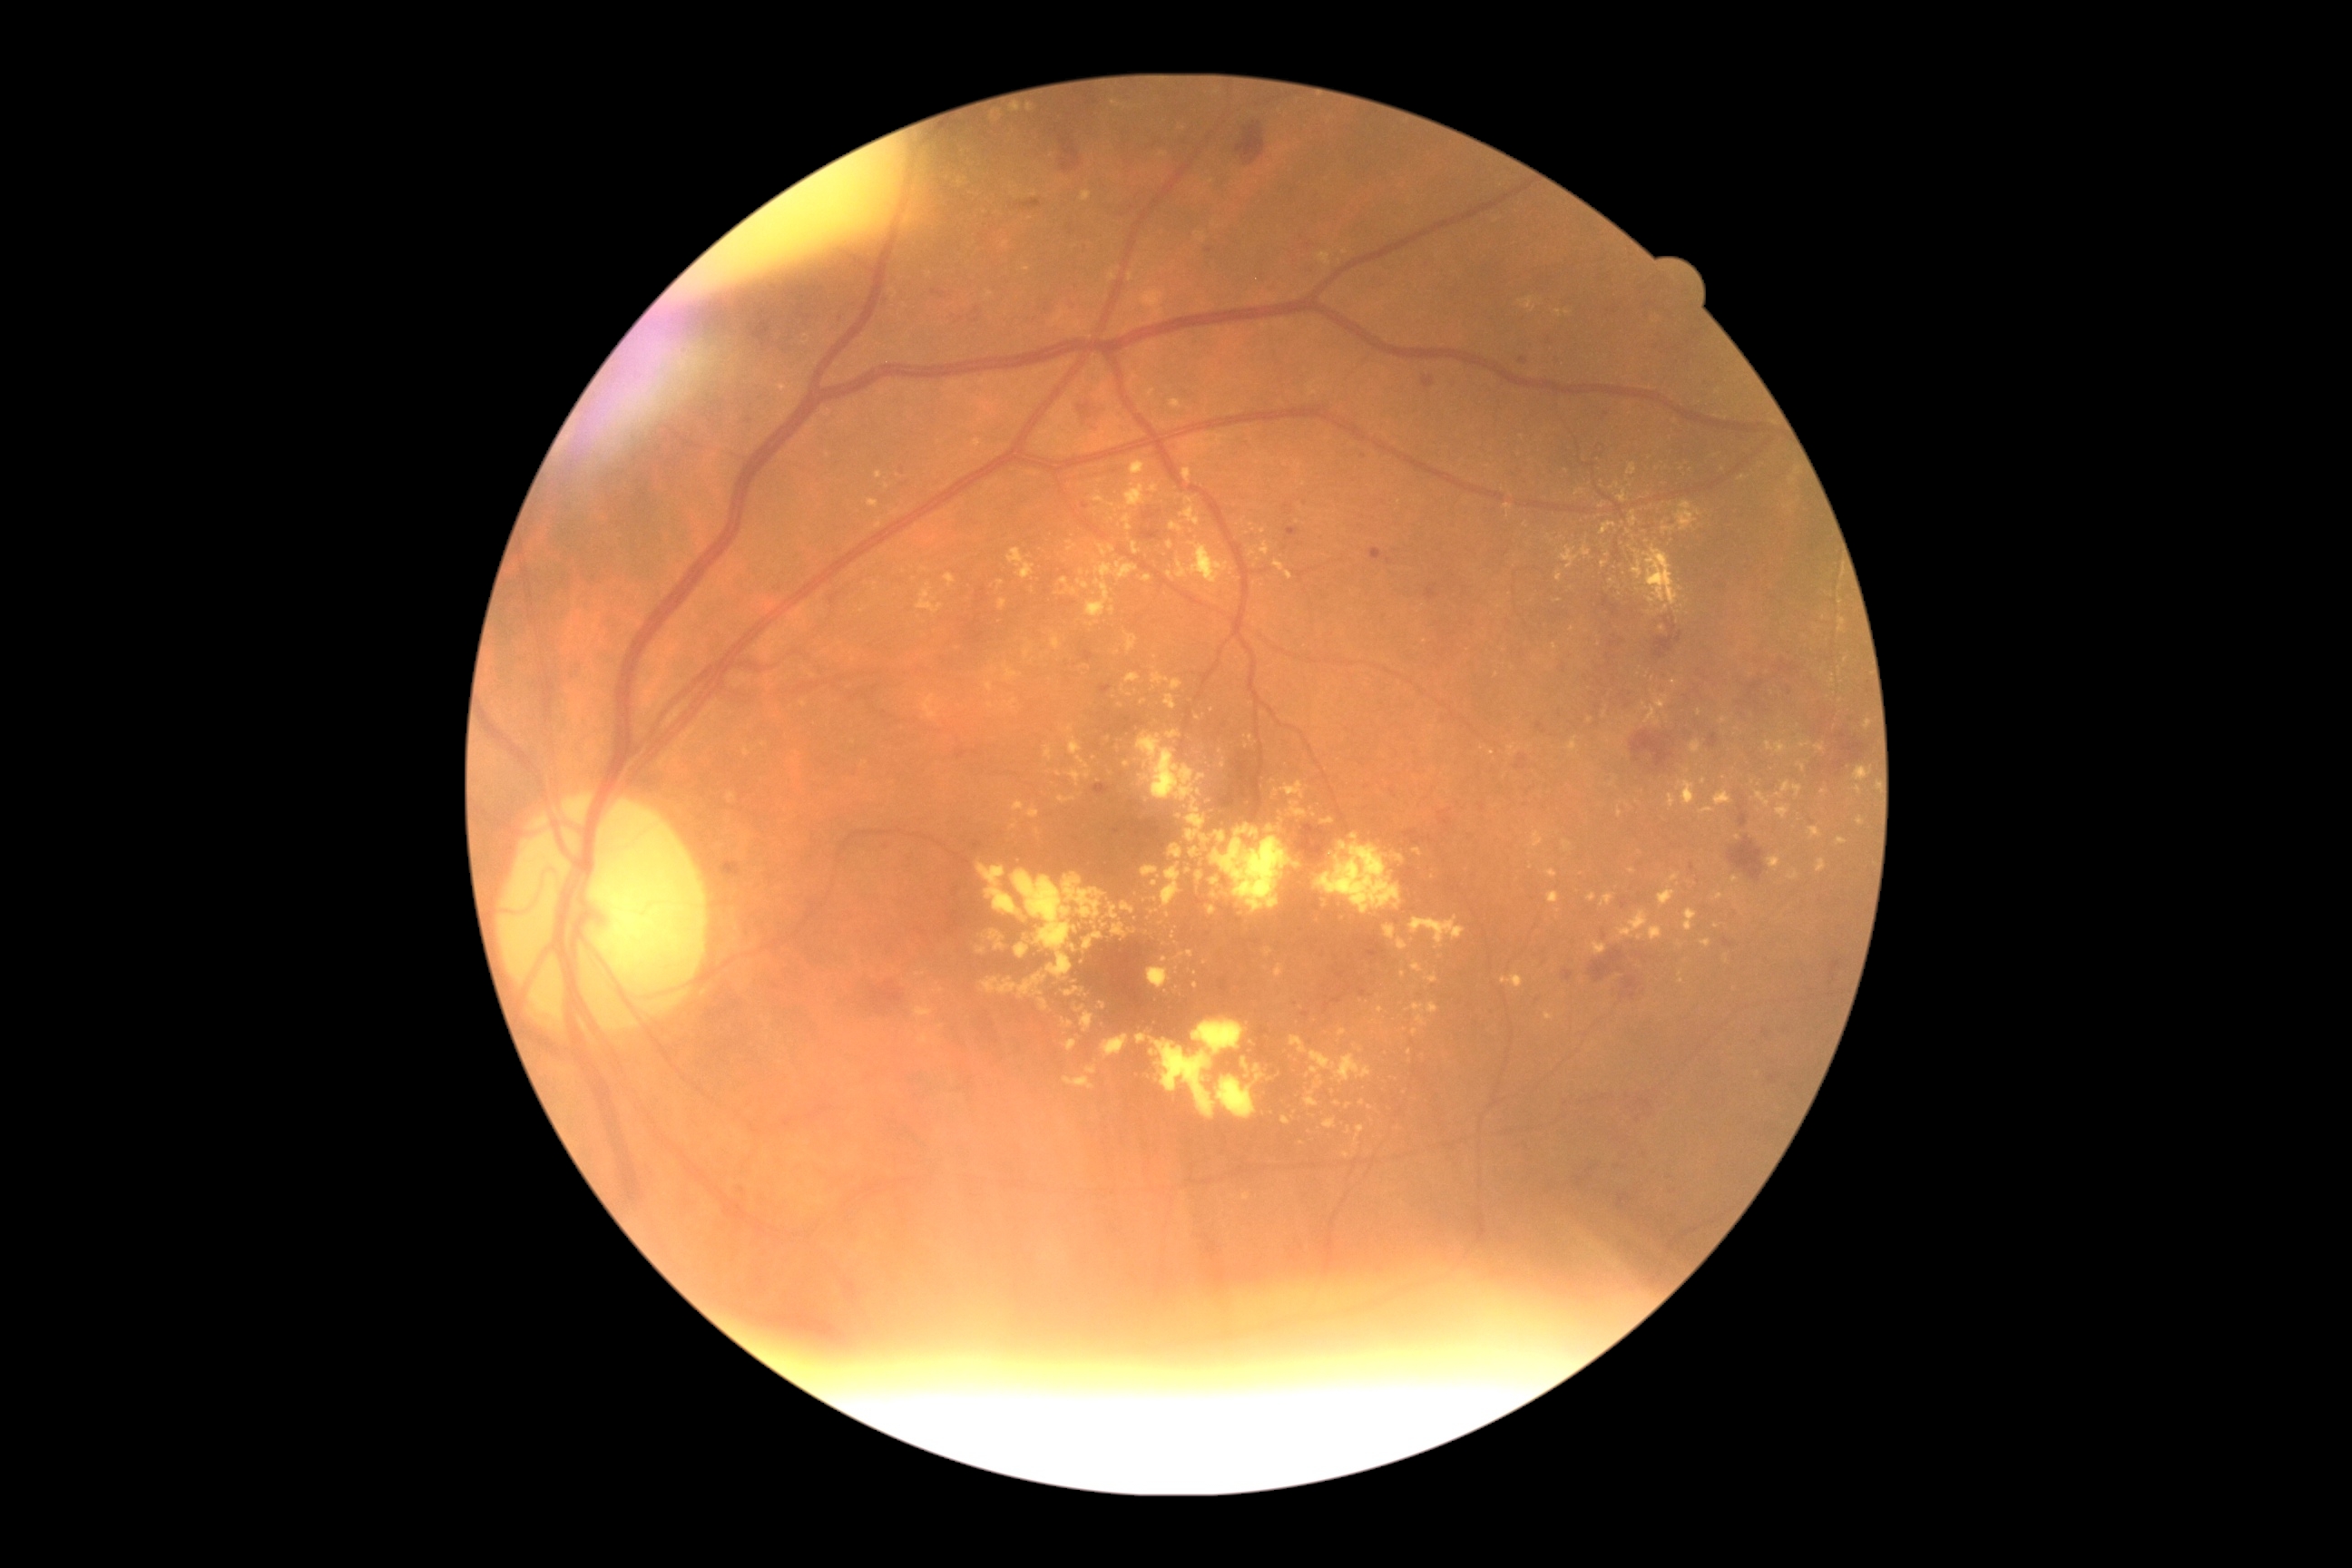

partial: true
dr_grade: 2
lesions:
  se: []
  ex:
    - rect(1690, 741, 1701, 754)
    - rect(1567, 738, 1578, 752)
    - rect(1084, 932, 1104, 950)
    - rect(1211, 825, 1300, 914)
    - rect(1266, 1073, 1284, 1088)
    - rect(1170, 400, 1182, 409)
    - rect(743, 834, 750, 845)
    - rect(1008, 549, 1035, 580)
    - rect(1057, 796, 1077, 805)
    - rect(1200, 836, 1210, 843)
    - rect(1814, 743, 1825, 752)
  ex_small_centers:
    - x=1793, y=481
    - x=1082, y=573
    - x=1716, y=926
    - x=1248, y=747
    - x=909, y=220
    - x=1346, y=1156
    - x=1271, y=828
    - x=1846, y=660
    - x=1666, y=610
  he:
    - rect(1491, 1269, 1520, 1280)
    - rect(1563, 970, 1574, 981)
    - rect(1099, 687, 1112, 694)
    - rect(1536, 1259, 1578, 1297)
    - rect(1068, 224, 1073, 235)
    - rect(1832, 732, 1868, 770)
    - rect(1620, 975, 1640, 1001)
    - rect(1141, 529, 1161, 542)
    - rect(1576, 1286, 1583, 1297)
    - rect(977, 589, 988, 605)
    - rect(1059, 132, 1081, 172)
    - rect(1729, 836, 1767, 883)
    - rect(1366, 937, 1386, 957)
  he_small_centers:
    - x=1443, y=814
    - x=1589, y=1300
    - x=1640, y=956
    - x=1552, y=1257
  ma:
    - rect(1607, 654, 1612, 669)
    - rect(1516, 756, 1529, 770)
    - rect(1767, 1126, 1779, 1135)
    - rect(956, 749, 968, 760)
    - rect(1709, 734, 1720, 749)
    - rect(972, 843, 983, 850)
    - rect(1286, 527, 1300, 540)
    - rect(1602, 593, 1620, 618)
  ma_small_centers:
    - x=1674, y=1191
    - x=1624, y=904
    - x=1305, y=1015
    - x=1607, y=414
    - x=1389, y=561
    - x=975, y=753